Nonmydriatic fundus photograph, CFP, NIDEK AFC-230, modified Davis classification: 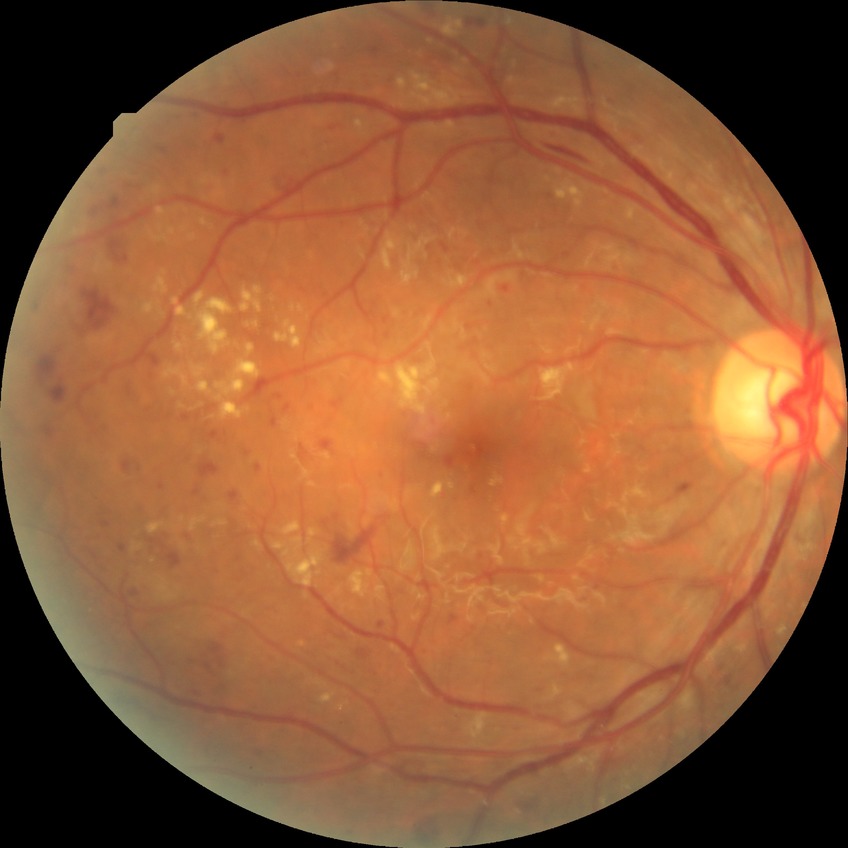
Diabetic retinopathy (DR) is pre-proliferative diabetic retinopathy (PPDR).